848 x 848 pixels
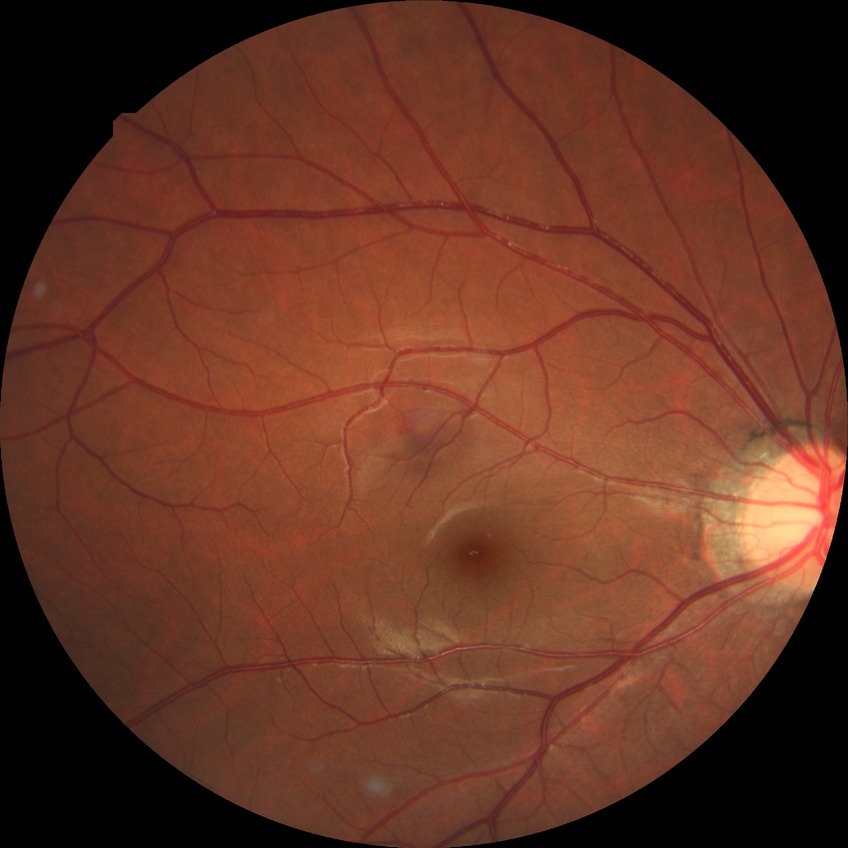

Diabetic retinopathy severity is no diabetic retinopathy.